2346x1568px: 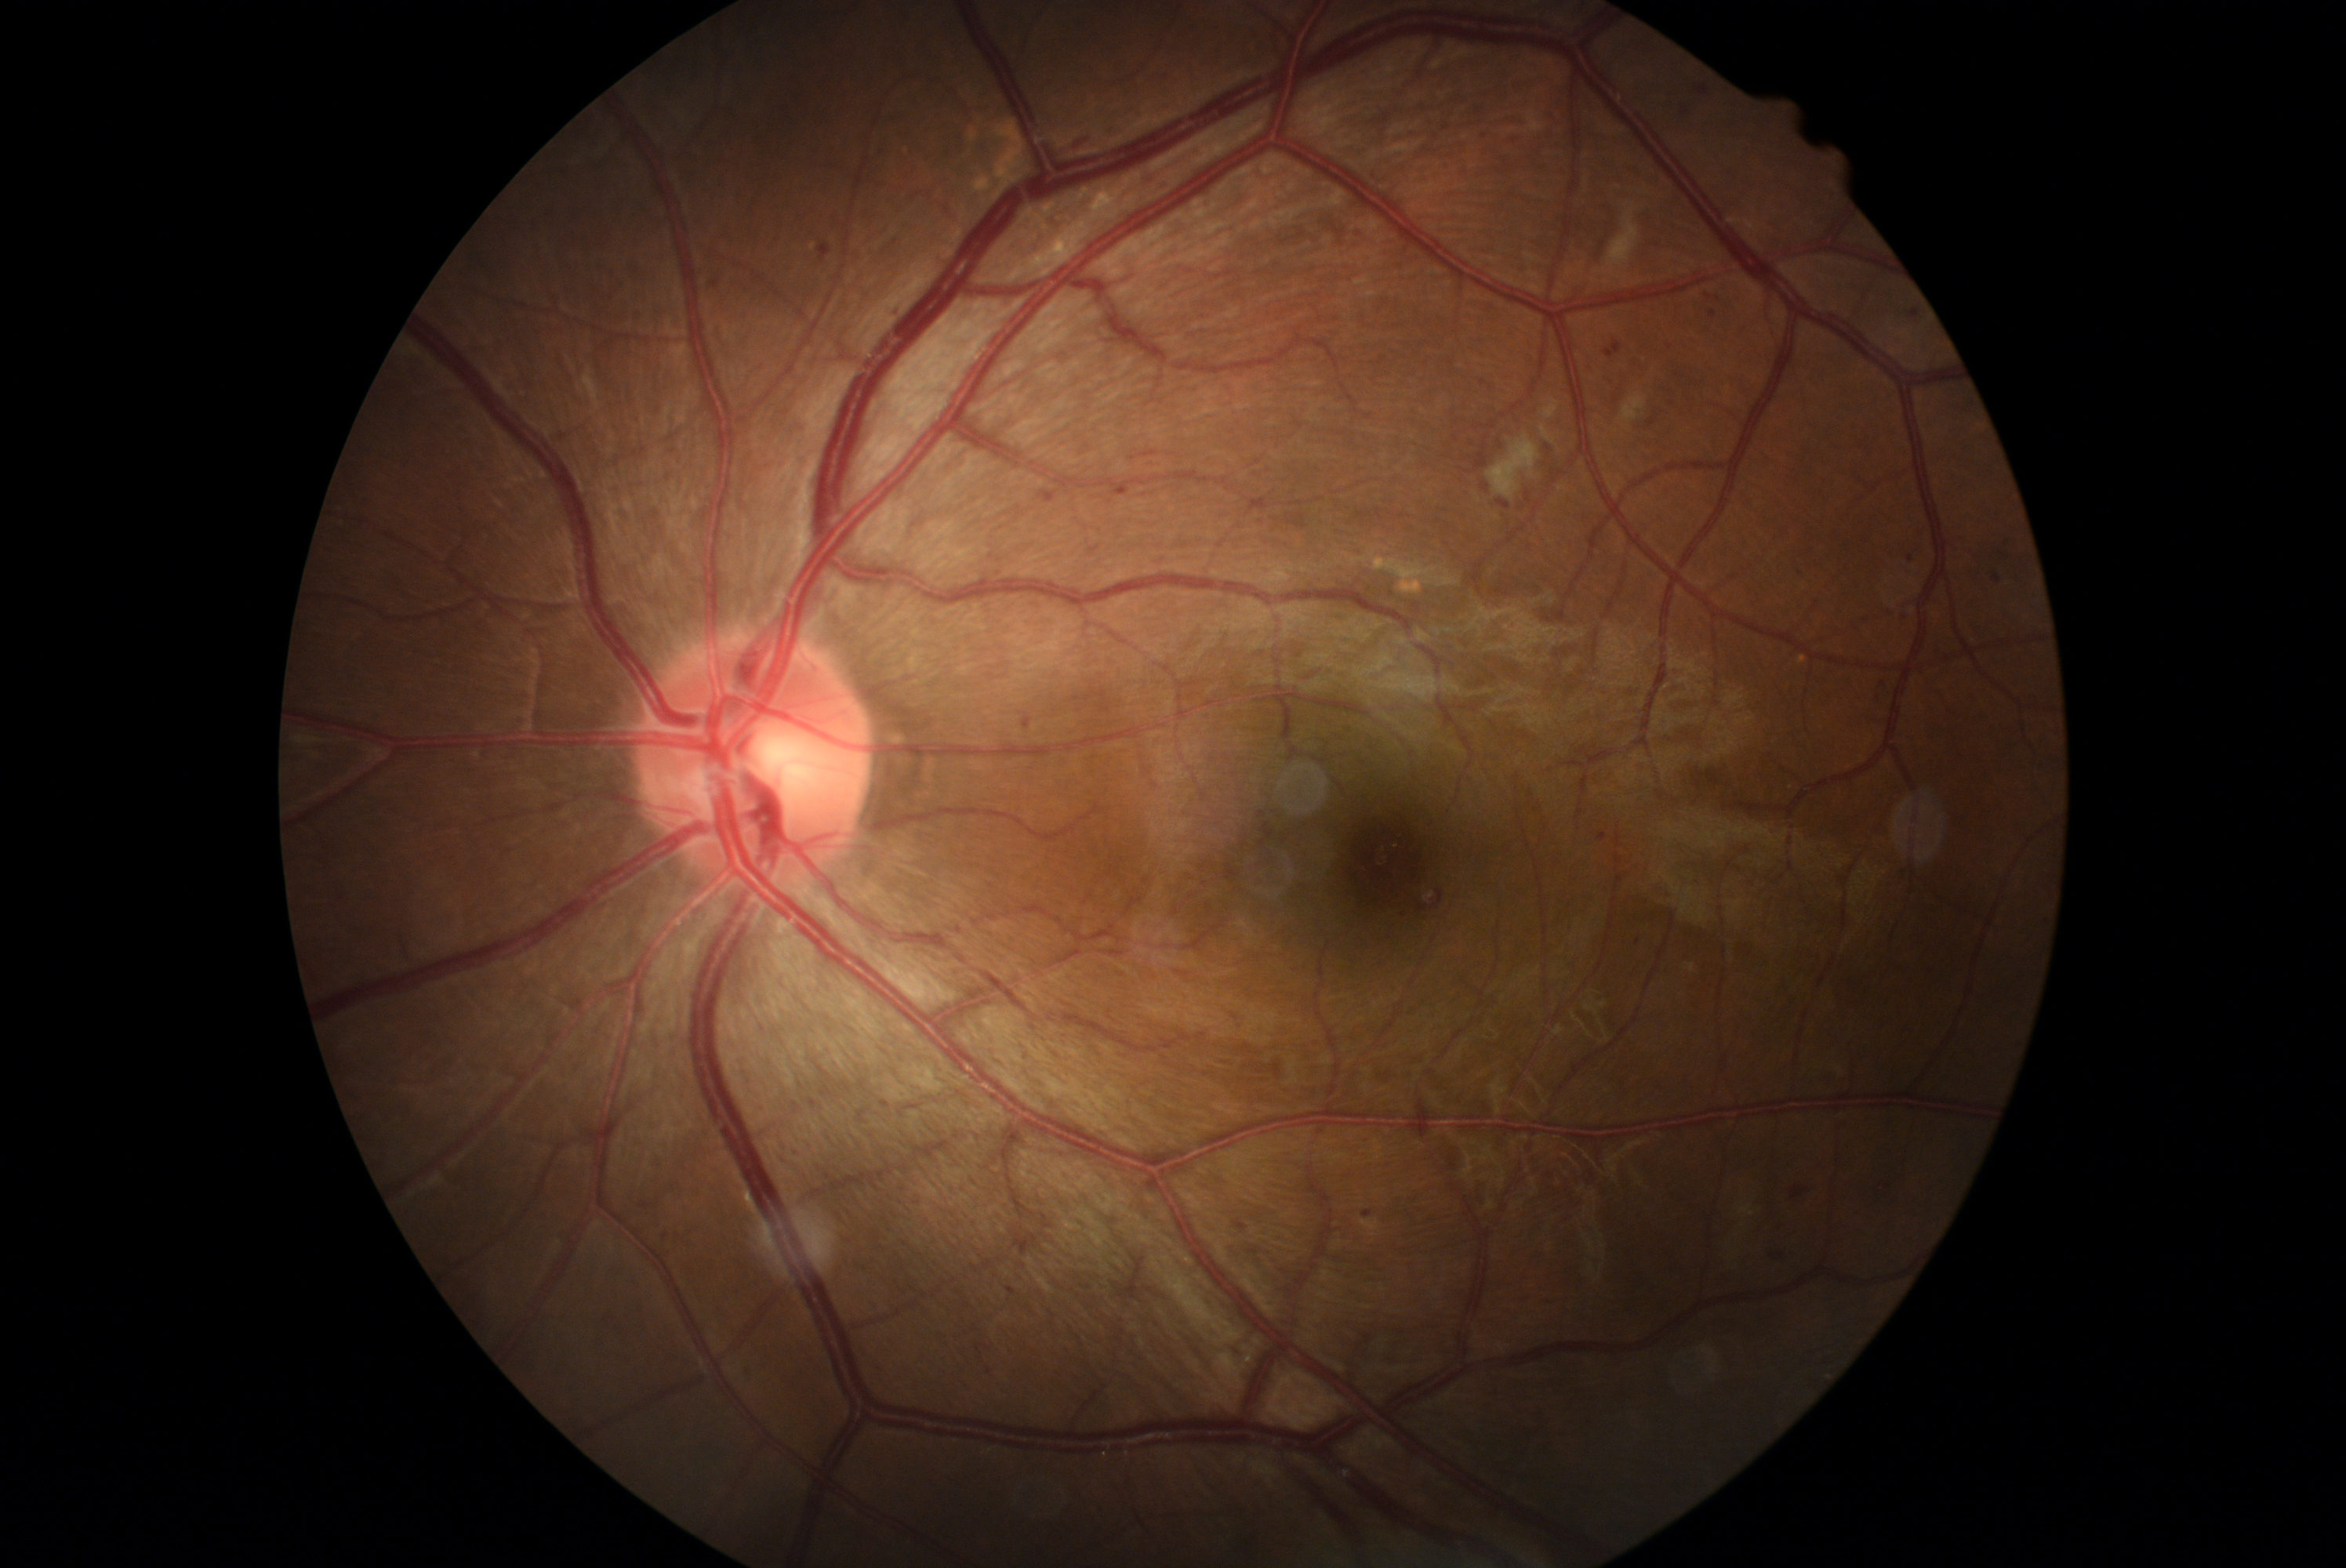

Diabetic retinopathy (DR) is grade 2 (moderate NPDR).